50-degree field of view. Color fundus photograph. 1932x1932:
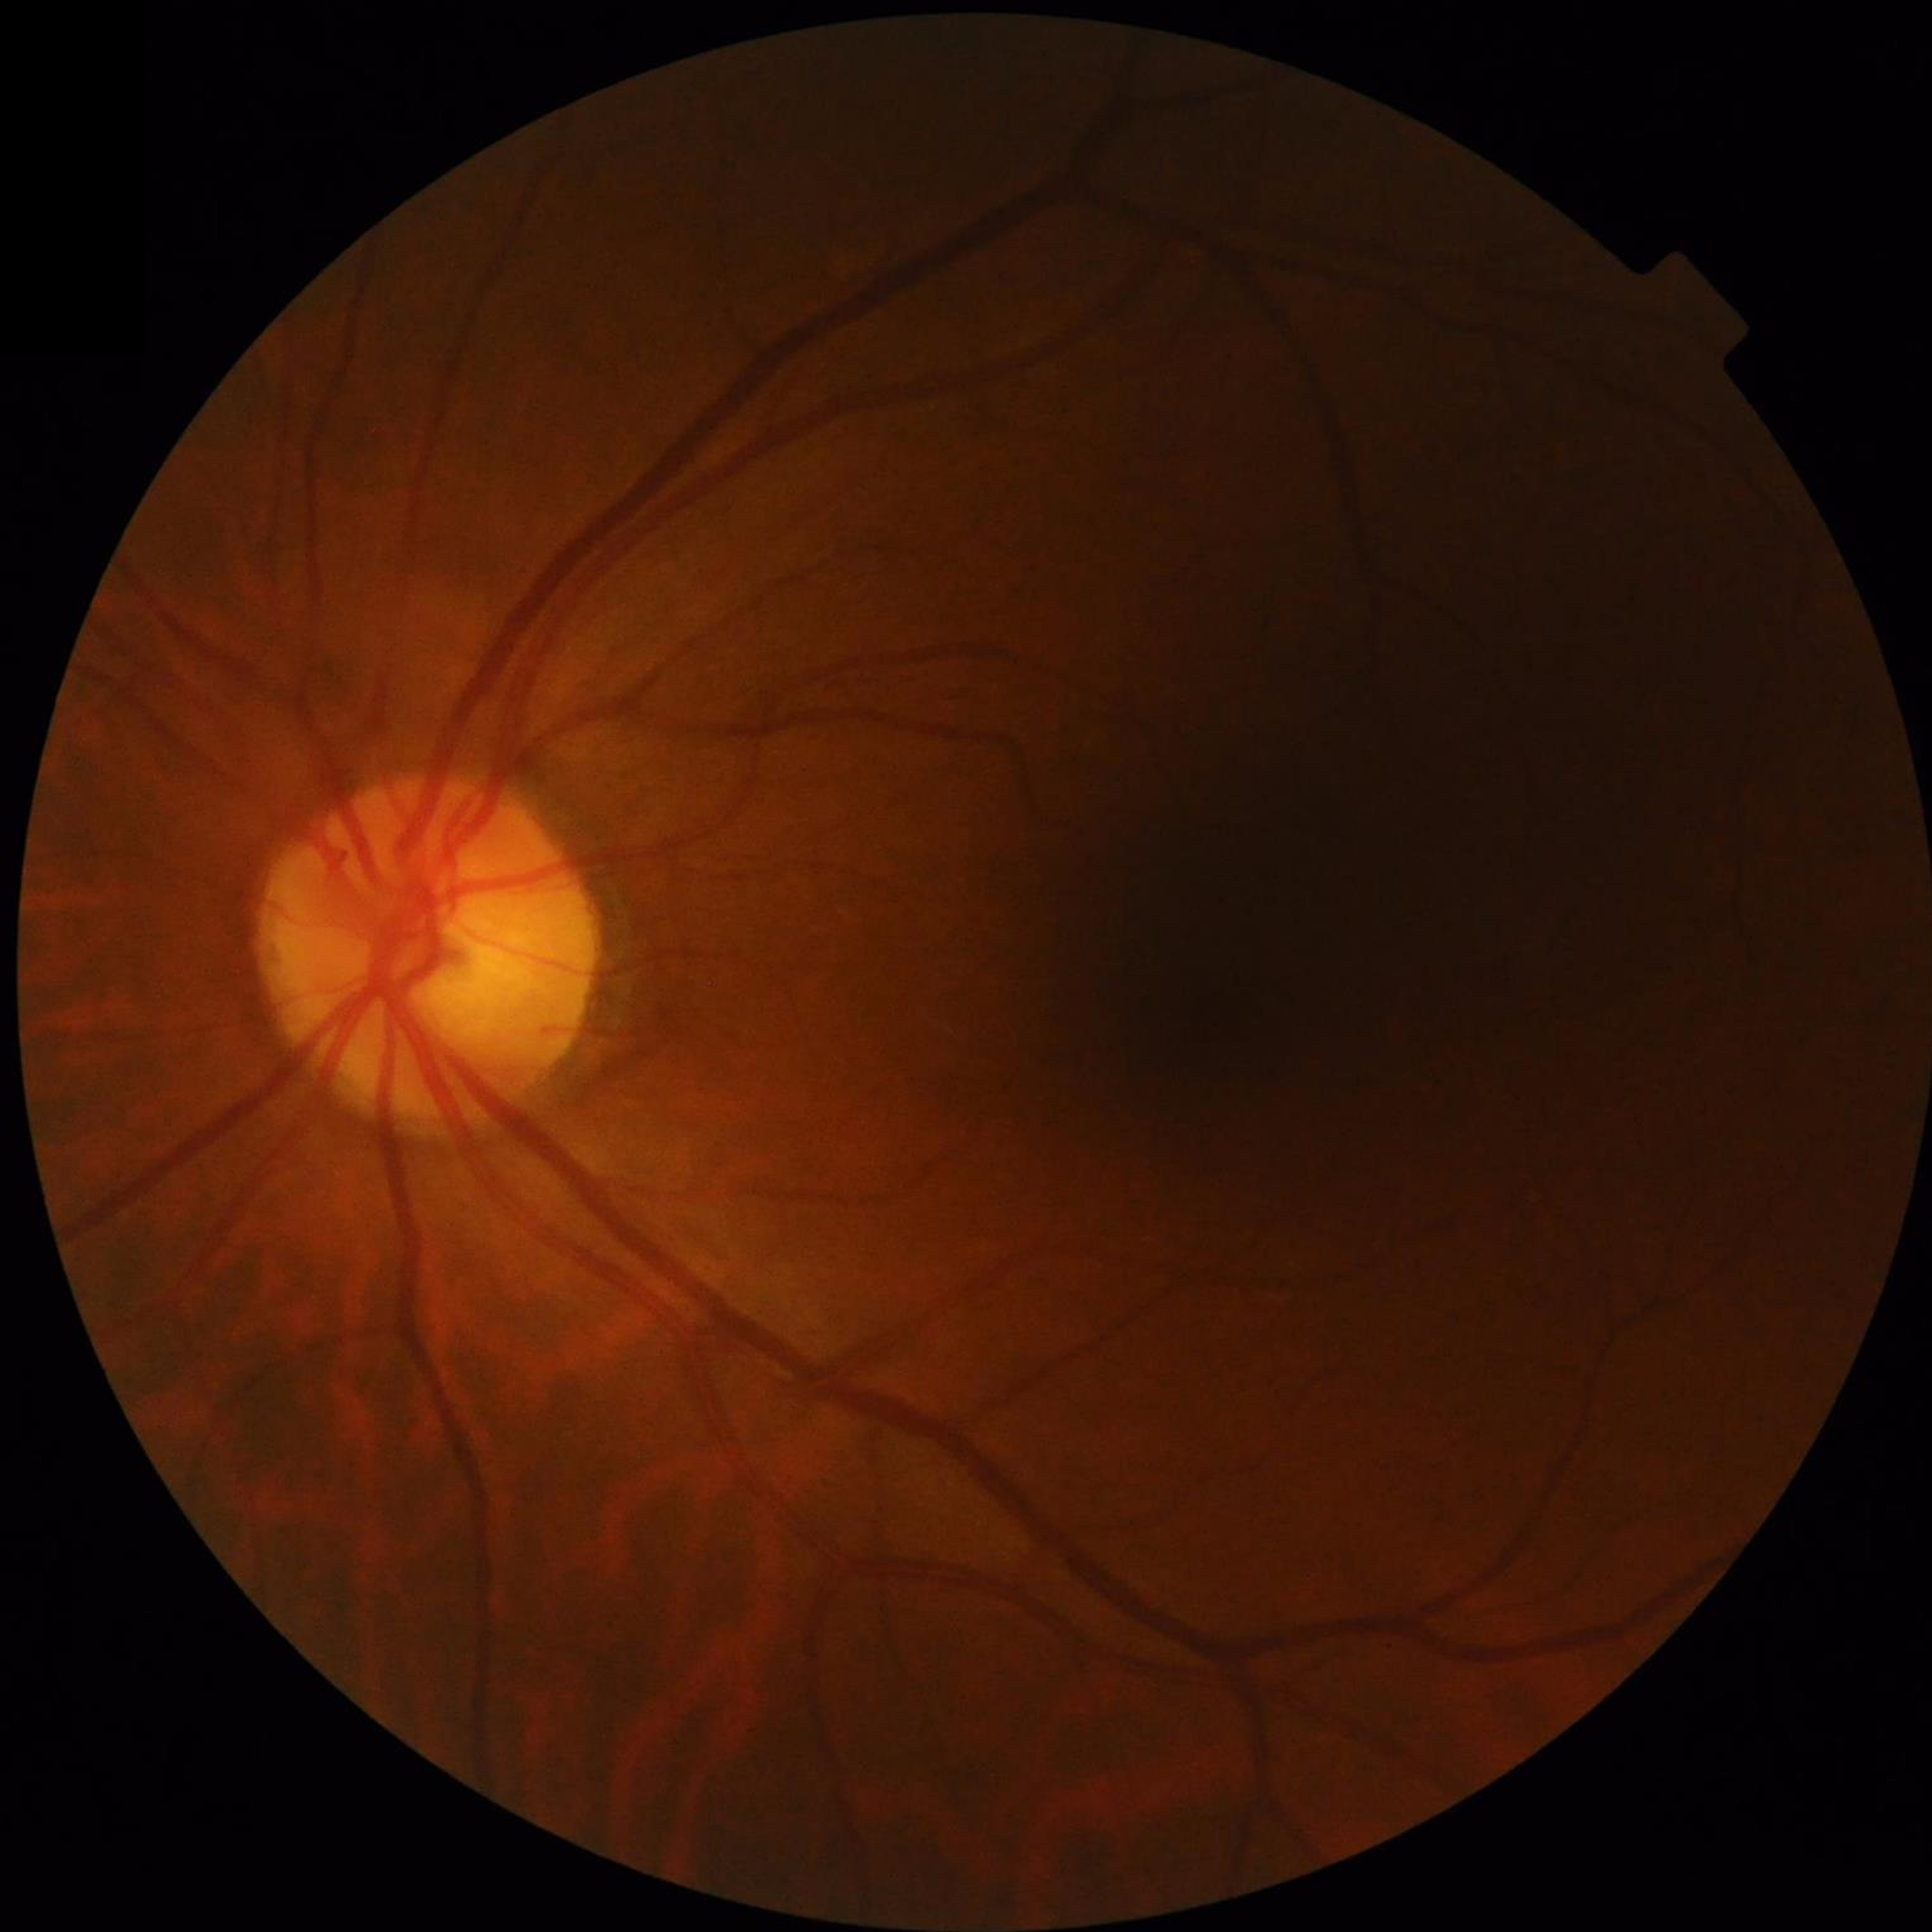
No AMD, DR, or glaucomatous findings.